Color fundus image · 45° field of view — 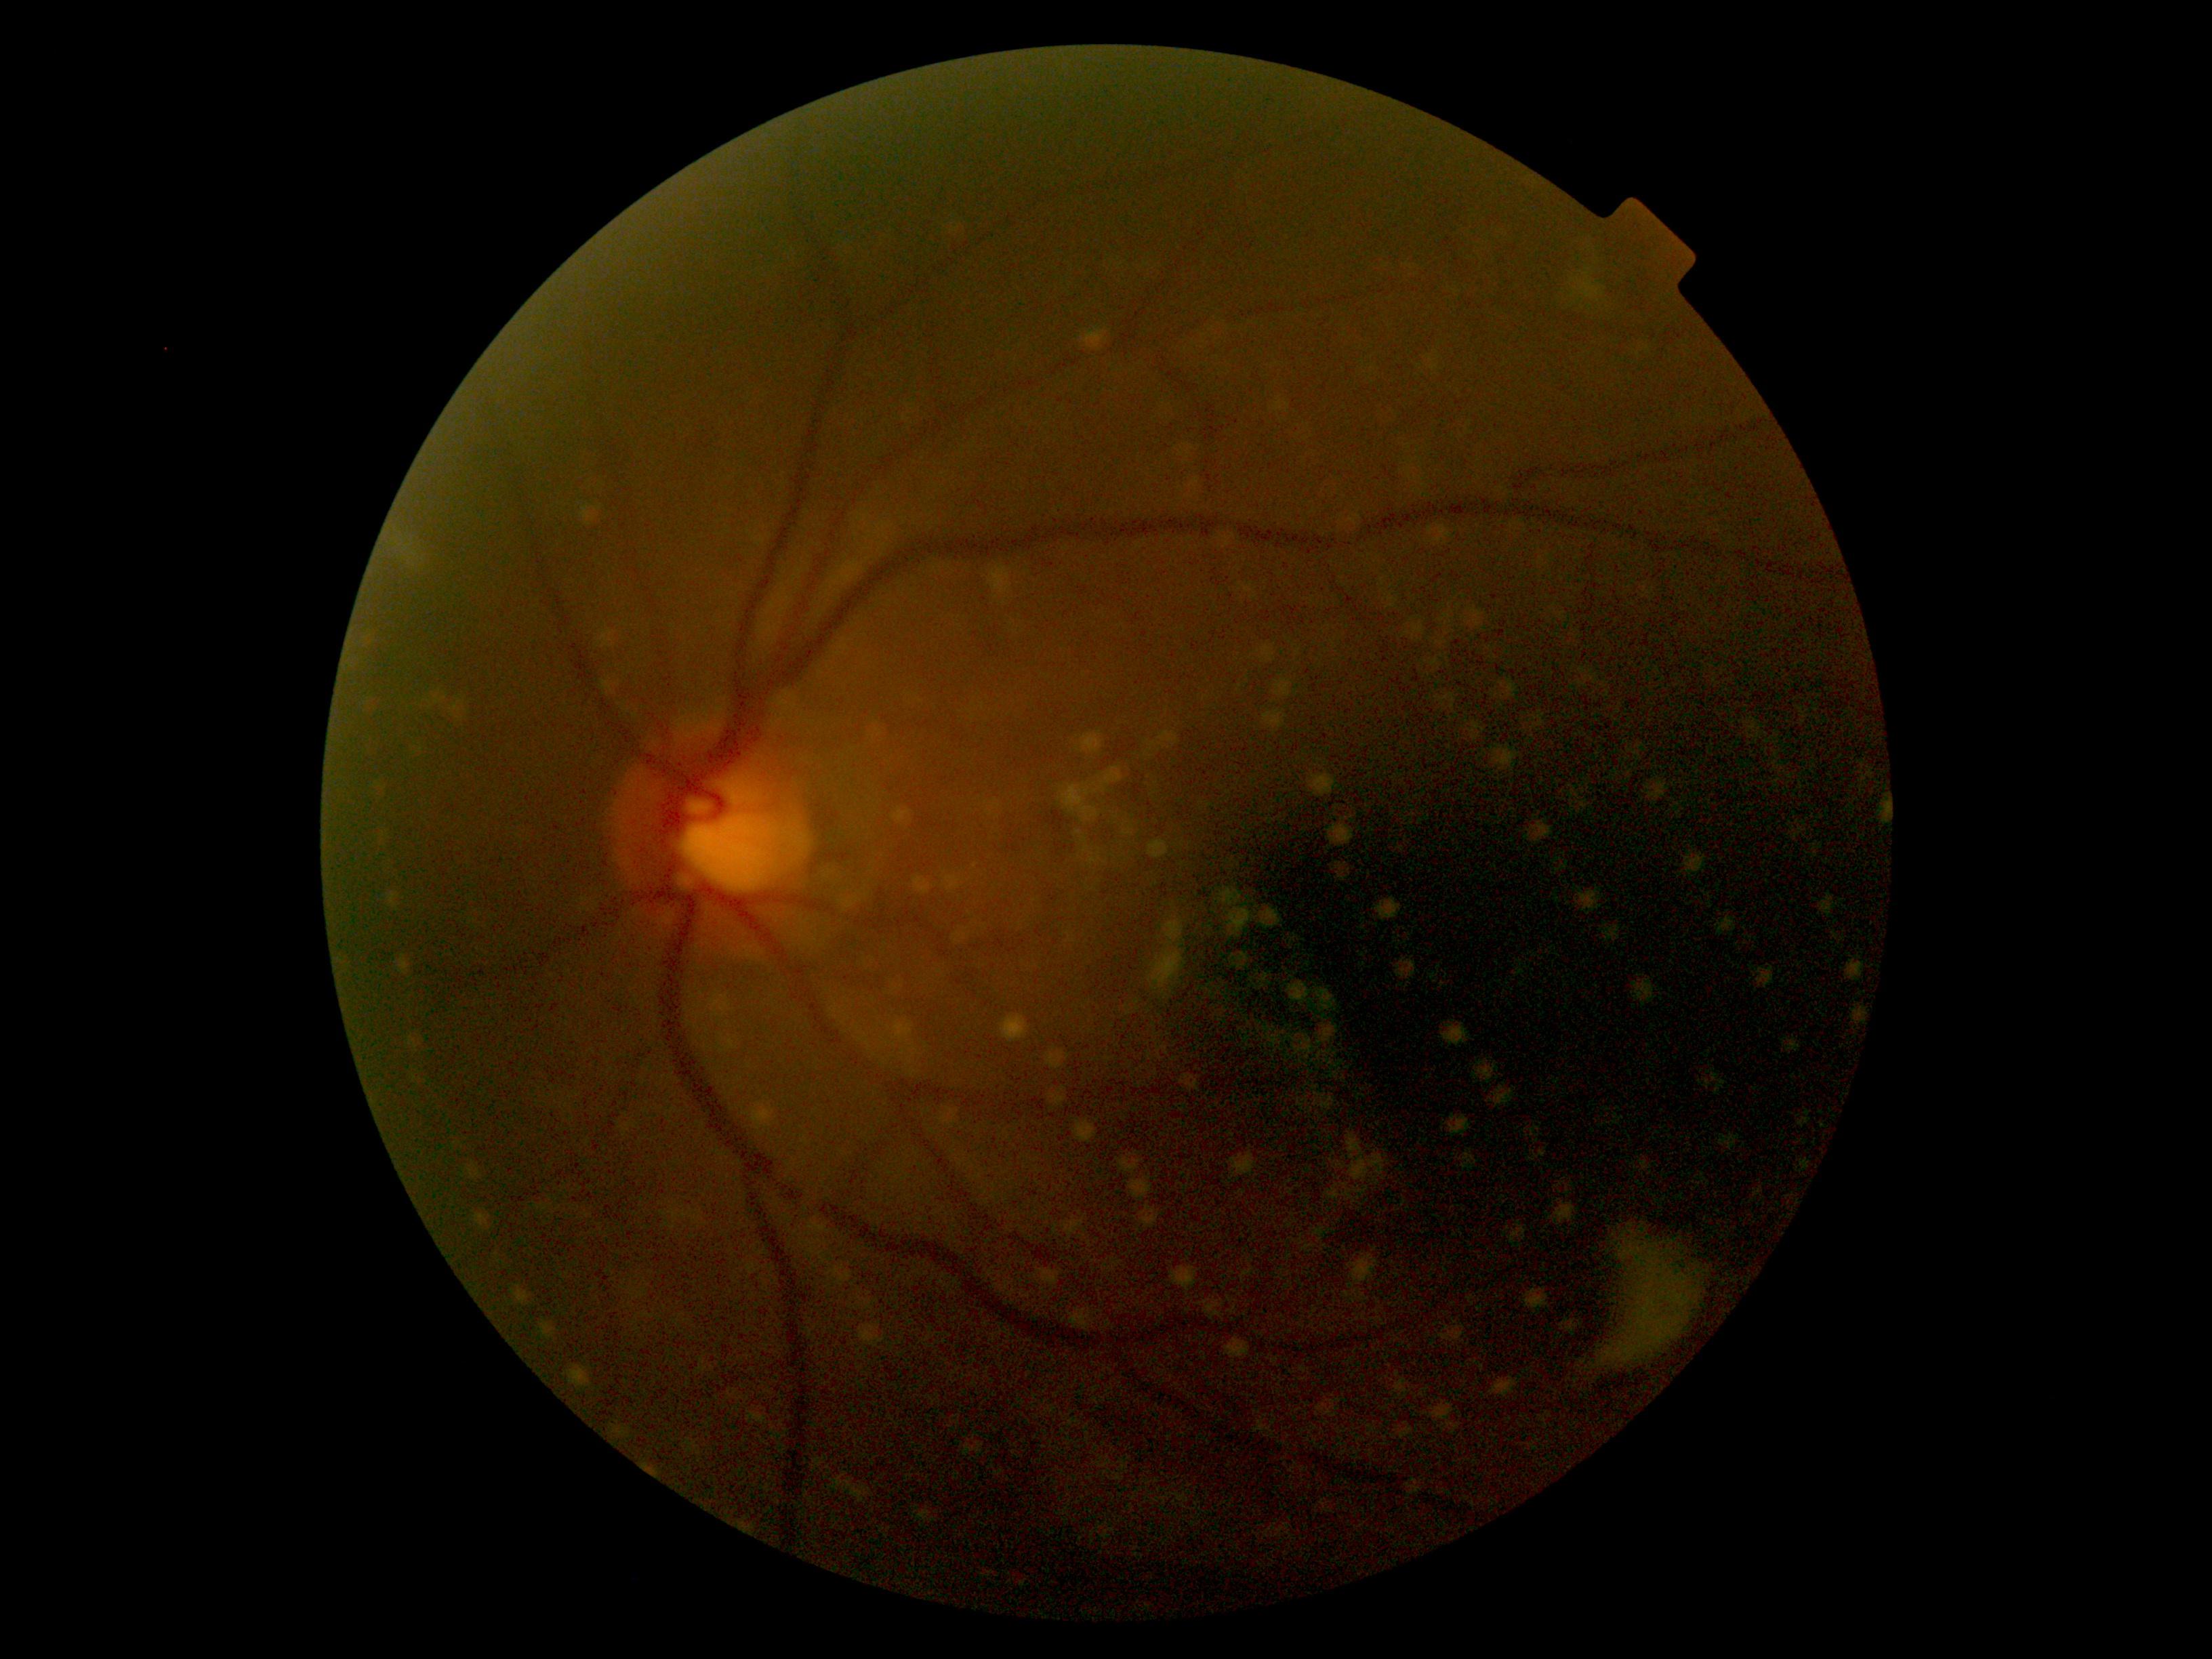 DR severity: ungradable. Quality too poor to assess for DR.